Graded on the modified Davis scale.
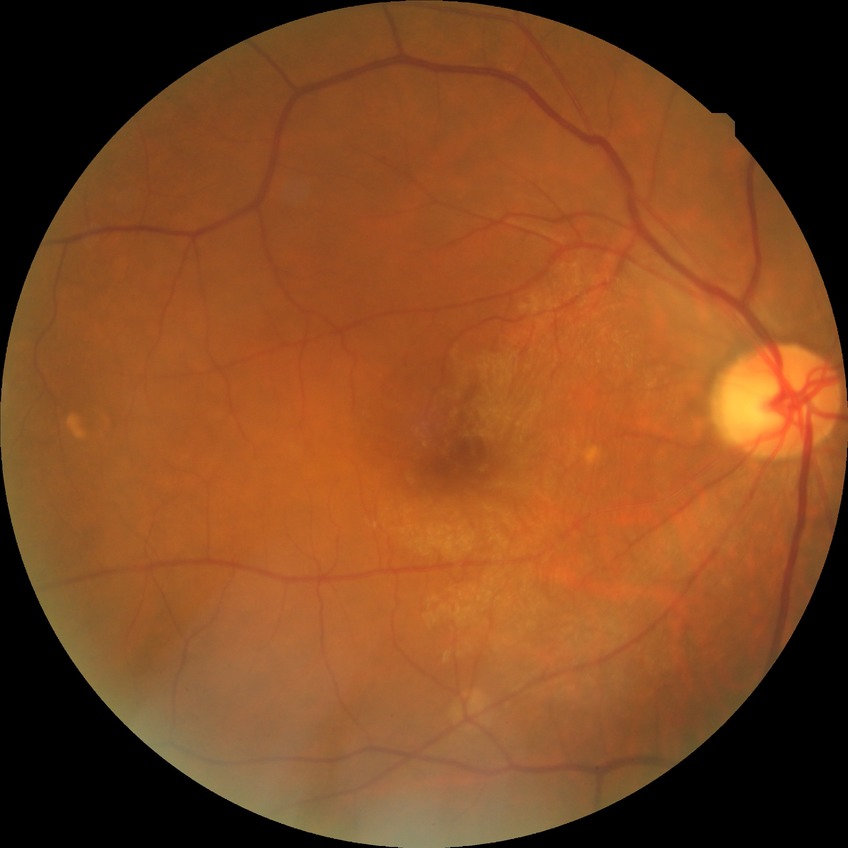 Diabetic retinopathy (DR) is NDR (no diabetic retinopathy).